848x848px · Davis DR grading · no pharmacologic dilation · fundus photo · NIDEK AFC-230 fundus camera: 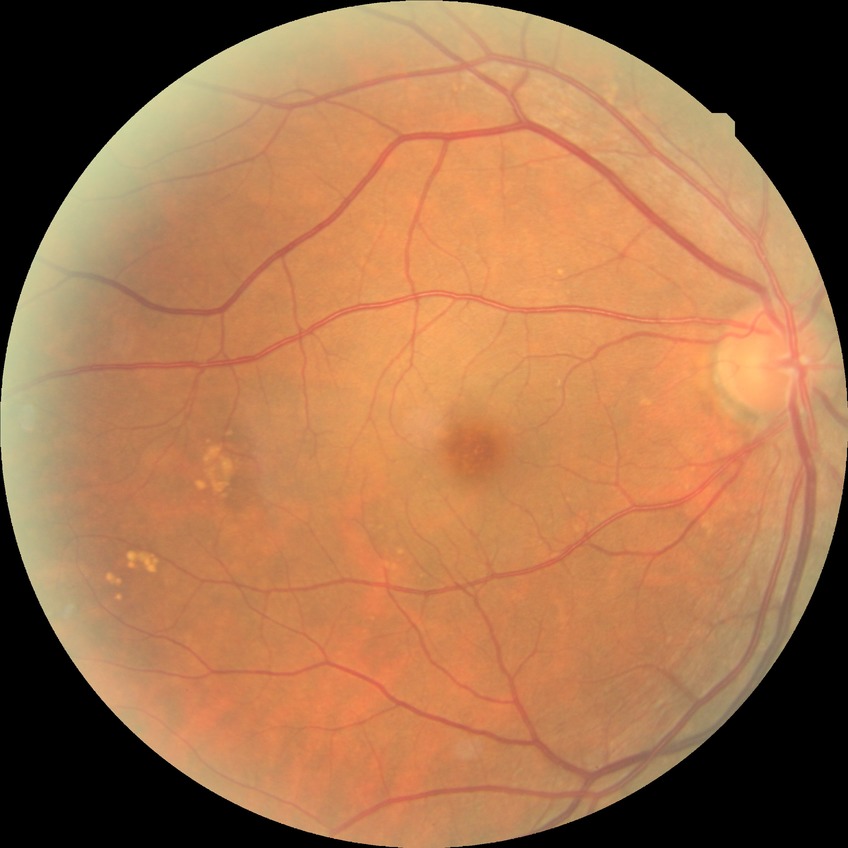
DR stage is NDR.